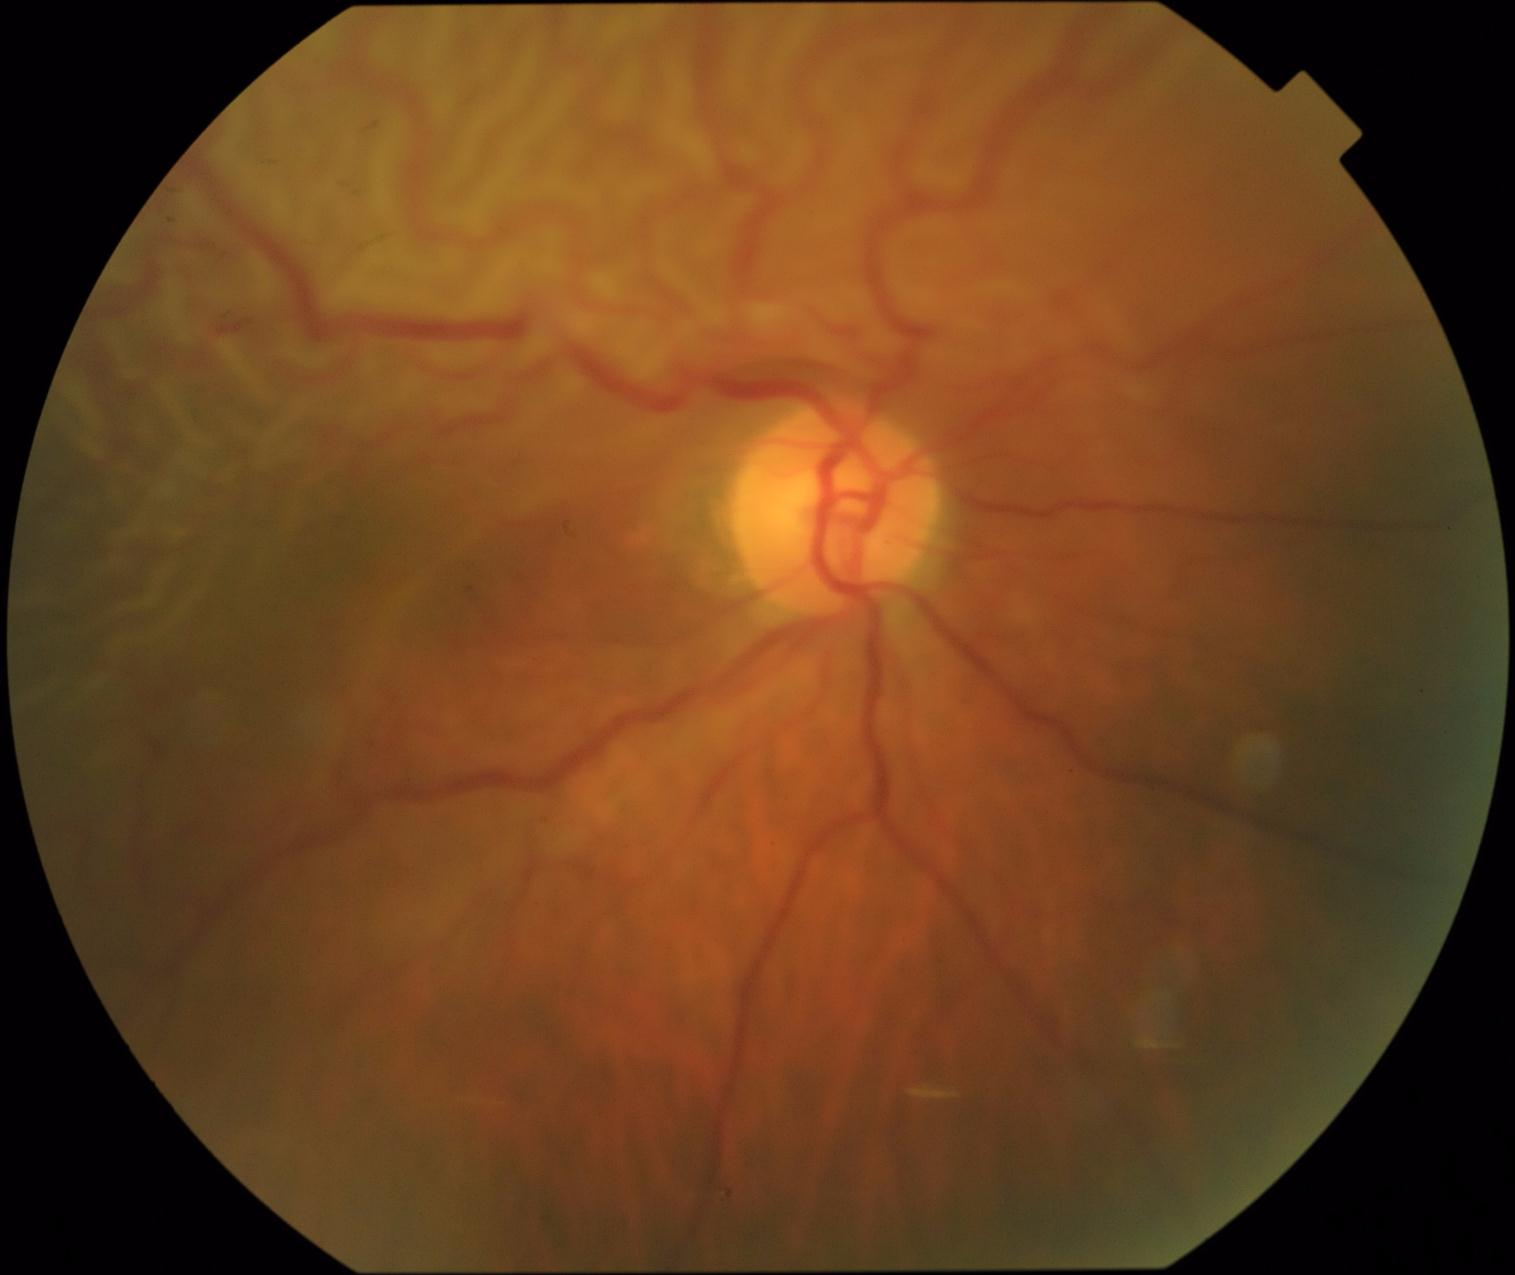
Findings:
– retinopathy grade — 4 (PDR)